45° FOV, nonmydriatic fundus photograph
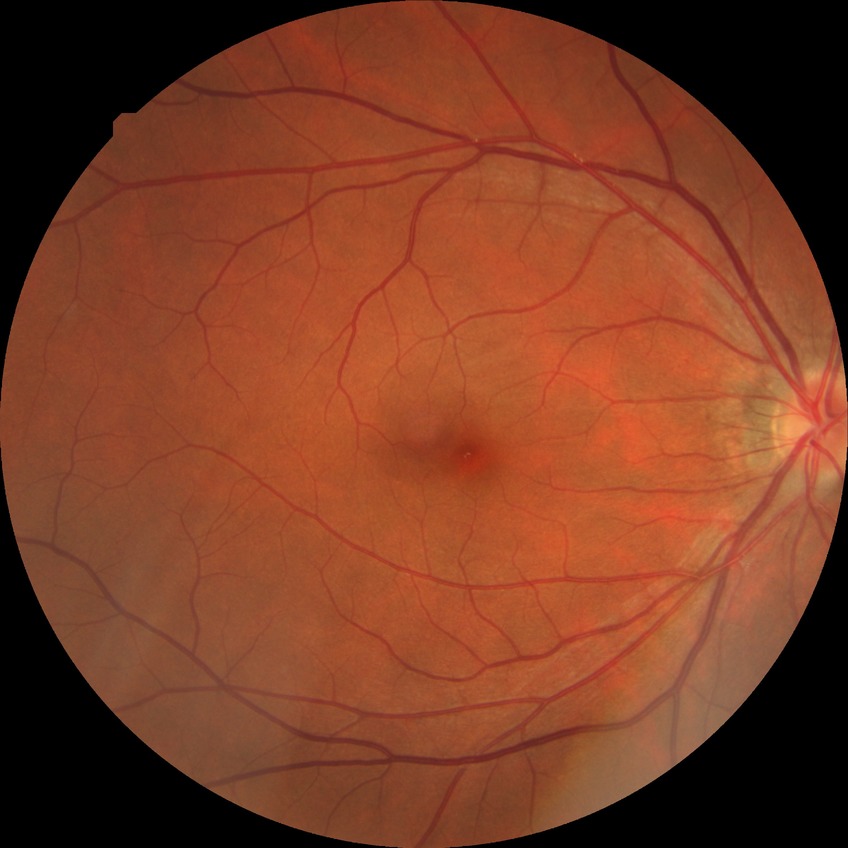
Diabetic retinopathy (DR) is NDR (no diabetic retinopathy).